Wide-field fundus photograph from neonatal ROP screening. 640 by 480 pixels — 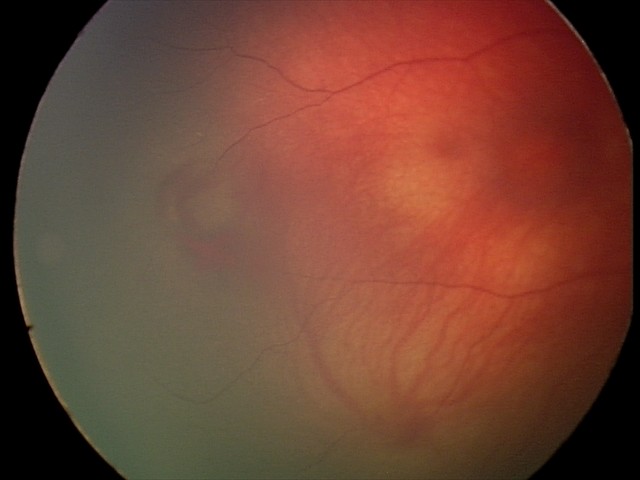

Examination diagnosed as retinal hemorrhages.